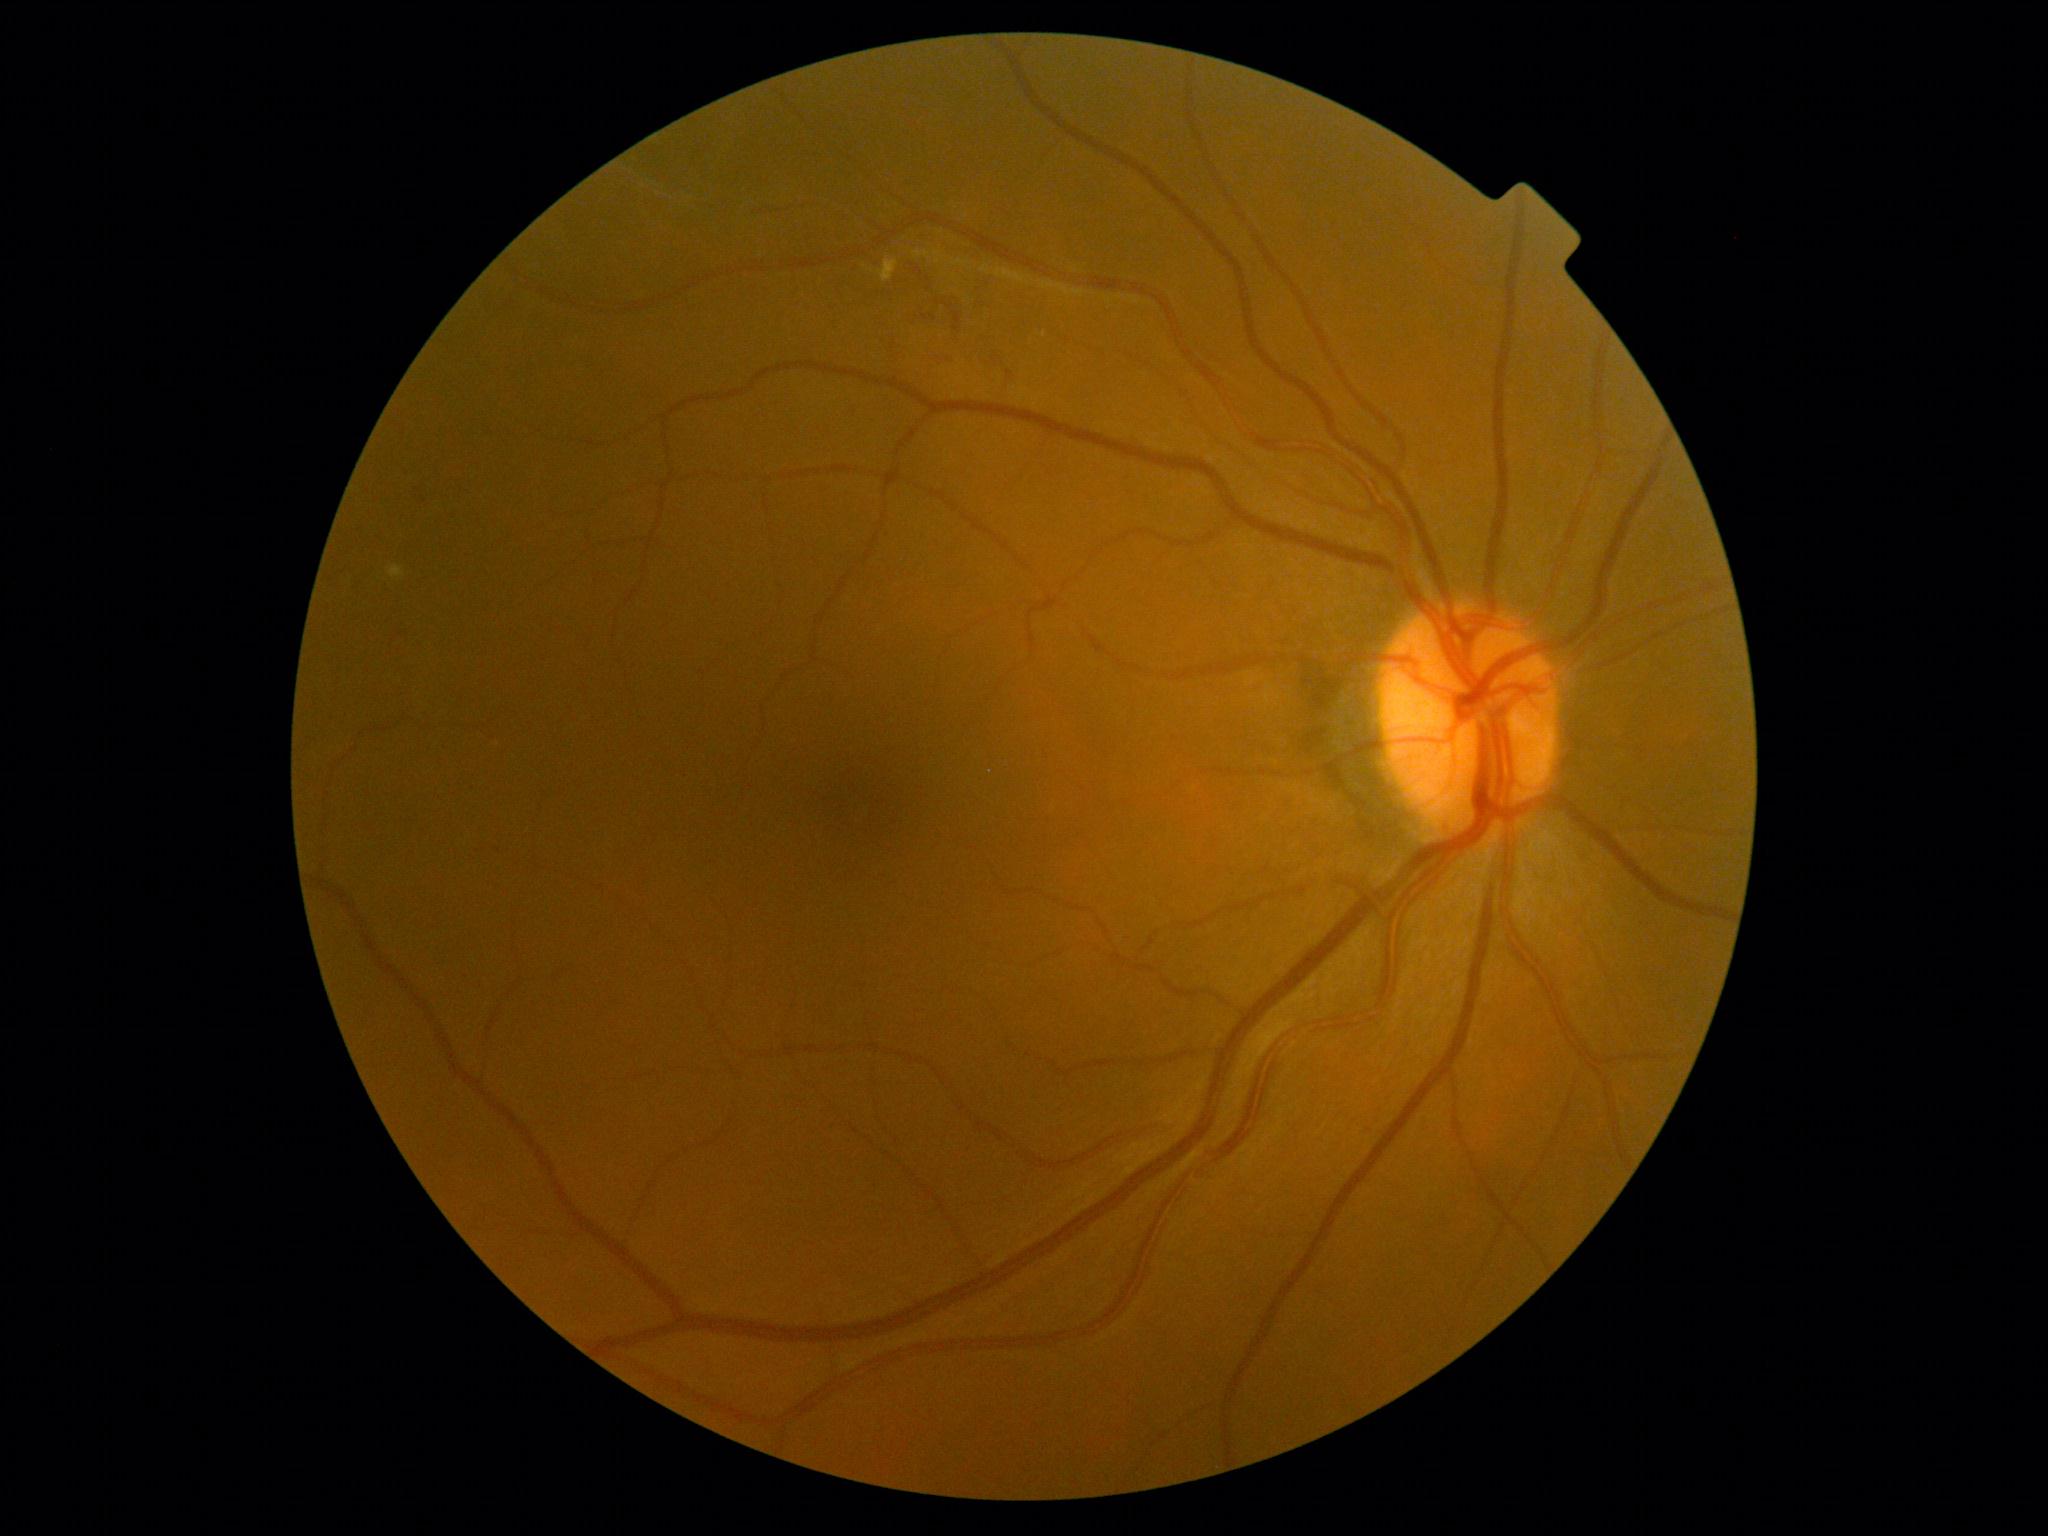 The retinopathy is classified as non-proliferative diabetic retinopathy. Diabetic retinopathy is grade 2 (moderate NPDR).